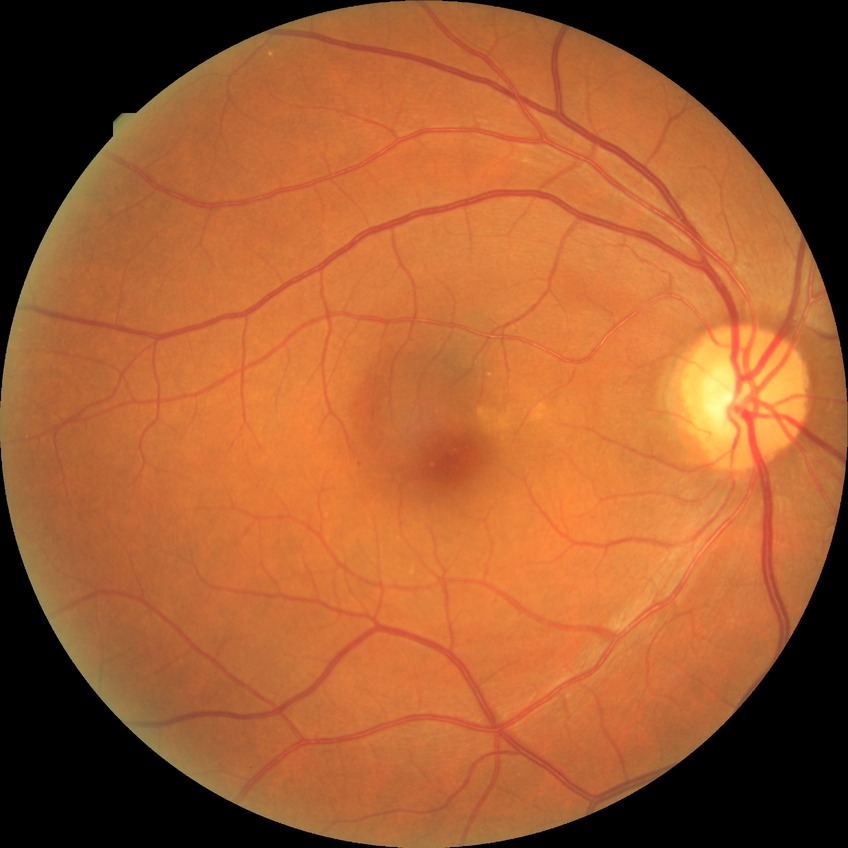 diabetic retinopathy stage=no diabetic retinopathy.